Color fundus photograph — 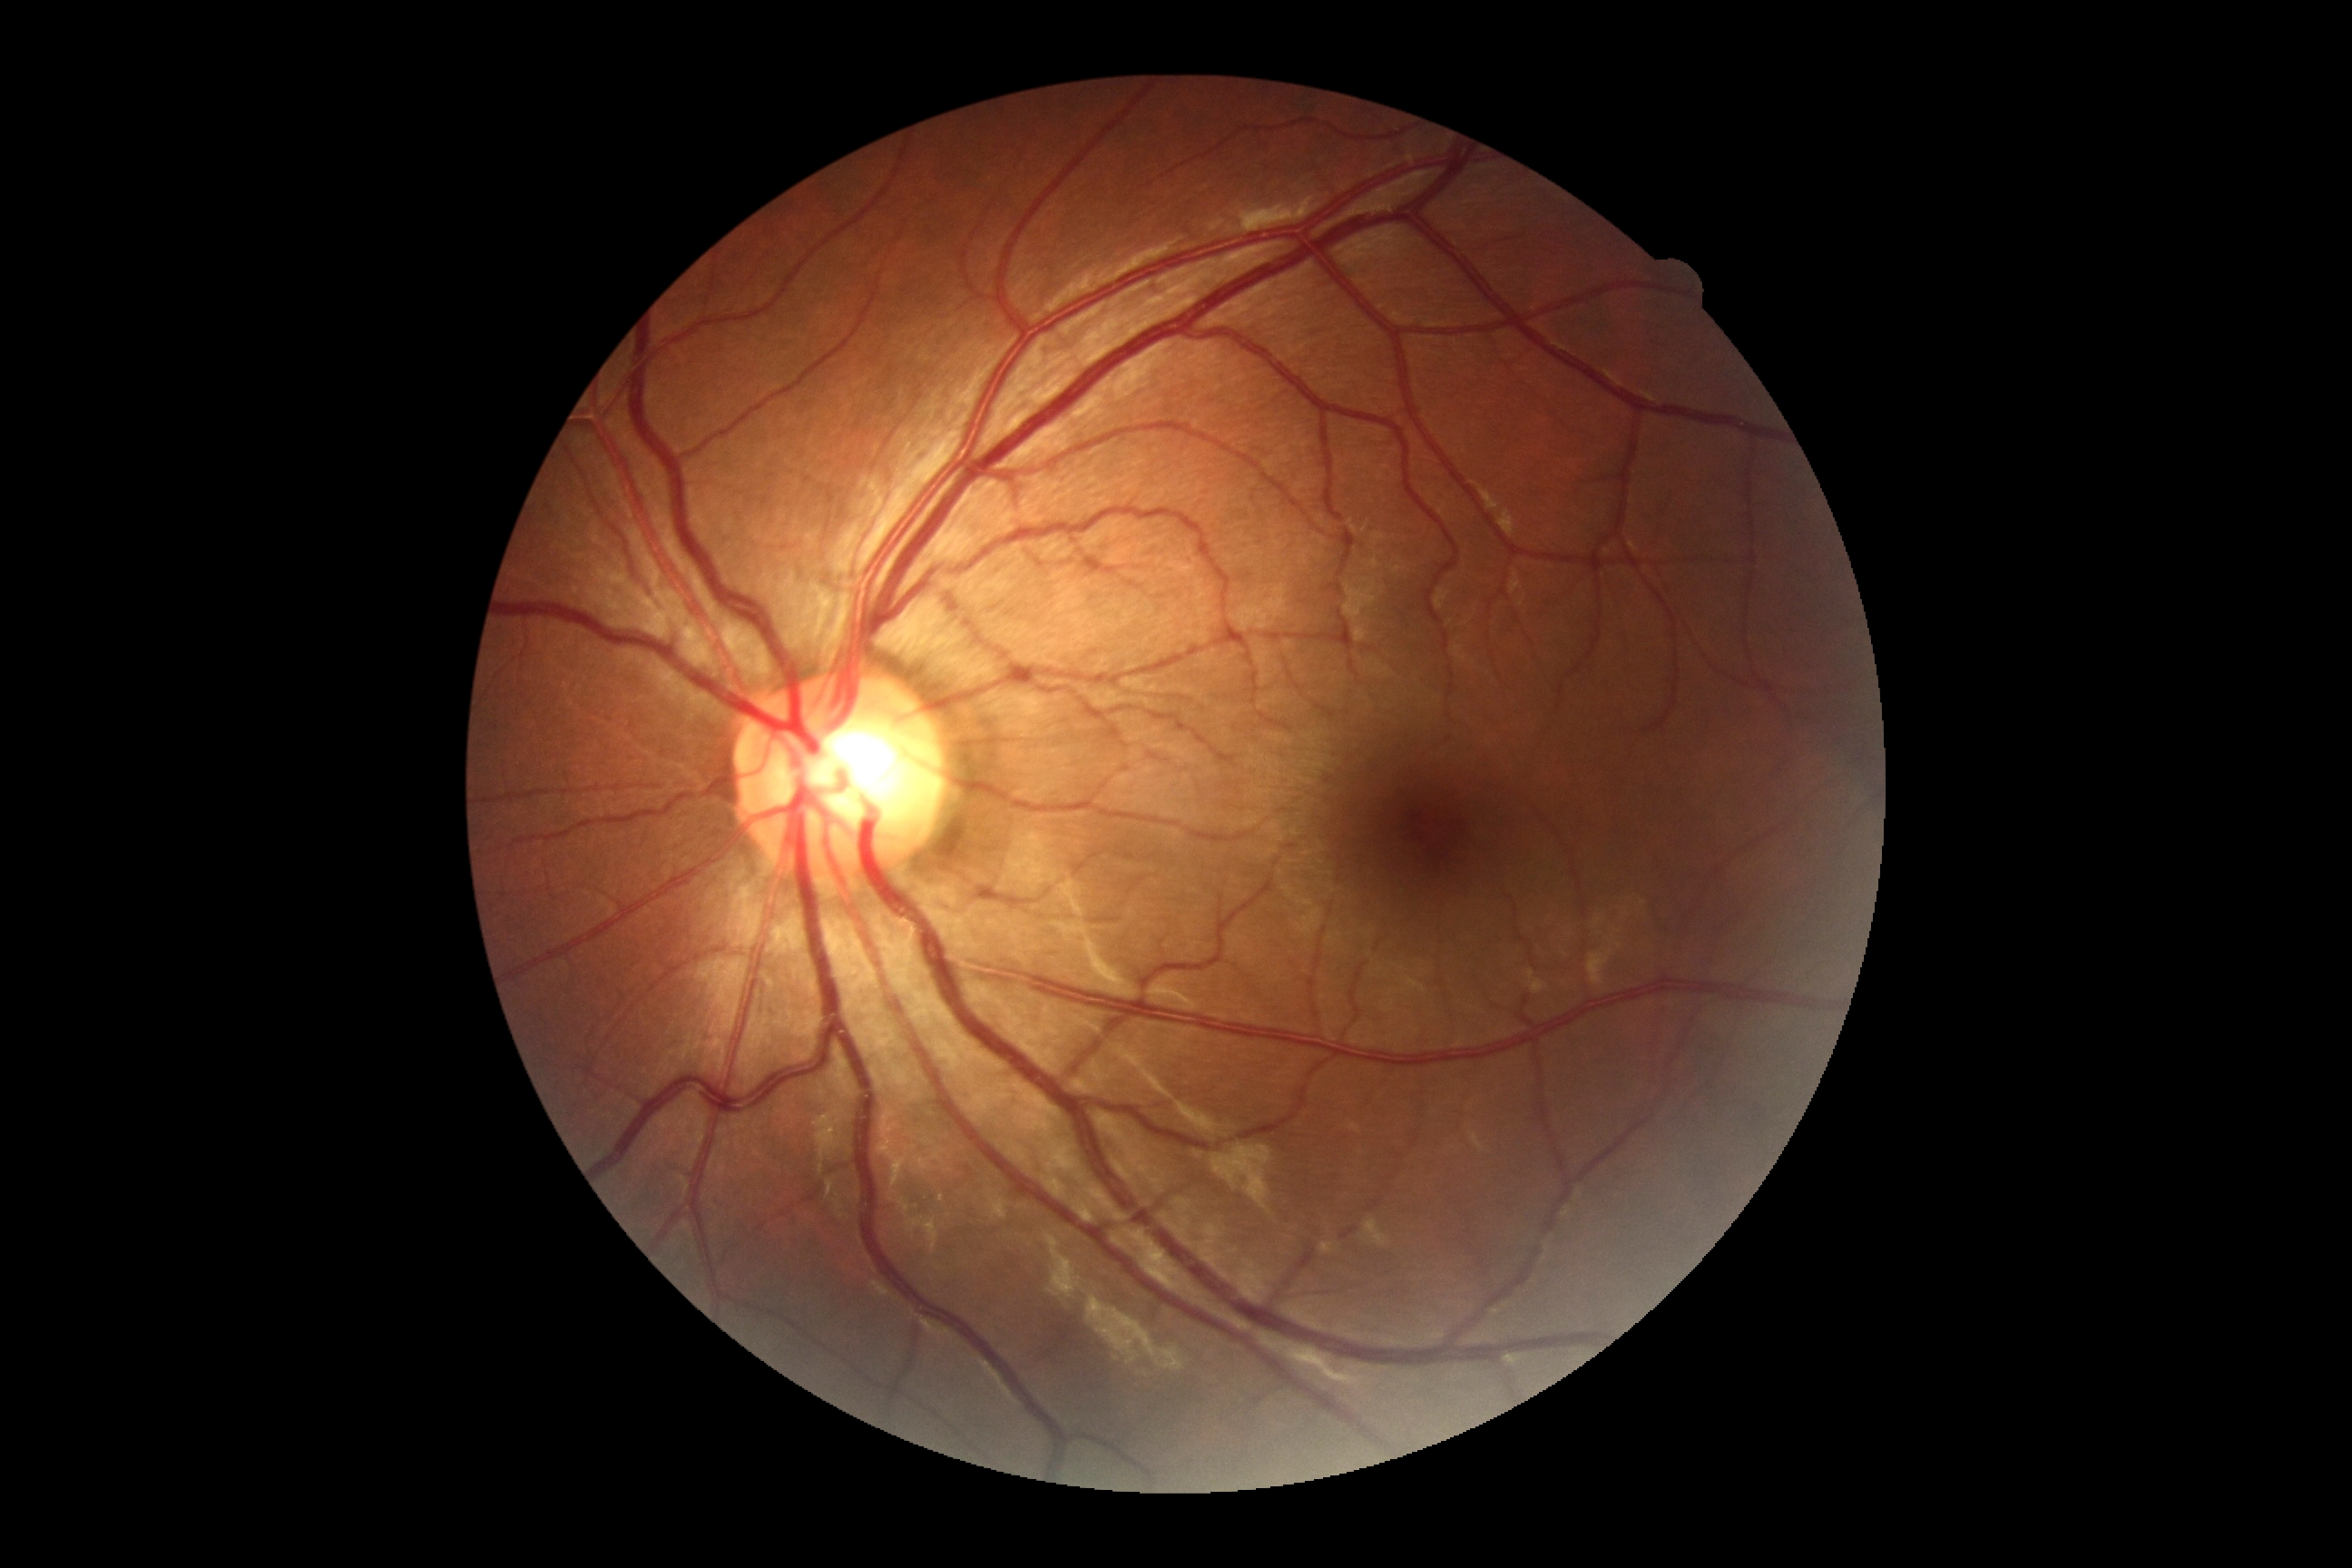
Diabetic retinopathy grade: no apparent retinopathy (0).